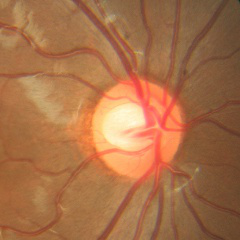
Q: What is the glaucoma diagnosis?
A: No glaucoma.